Acquired on the Phoenix ICON. Wide-field fundus photograph from neonatal ROP screening. 1240x1240px: 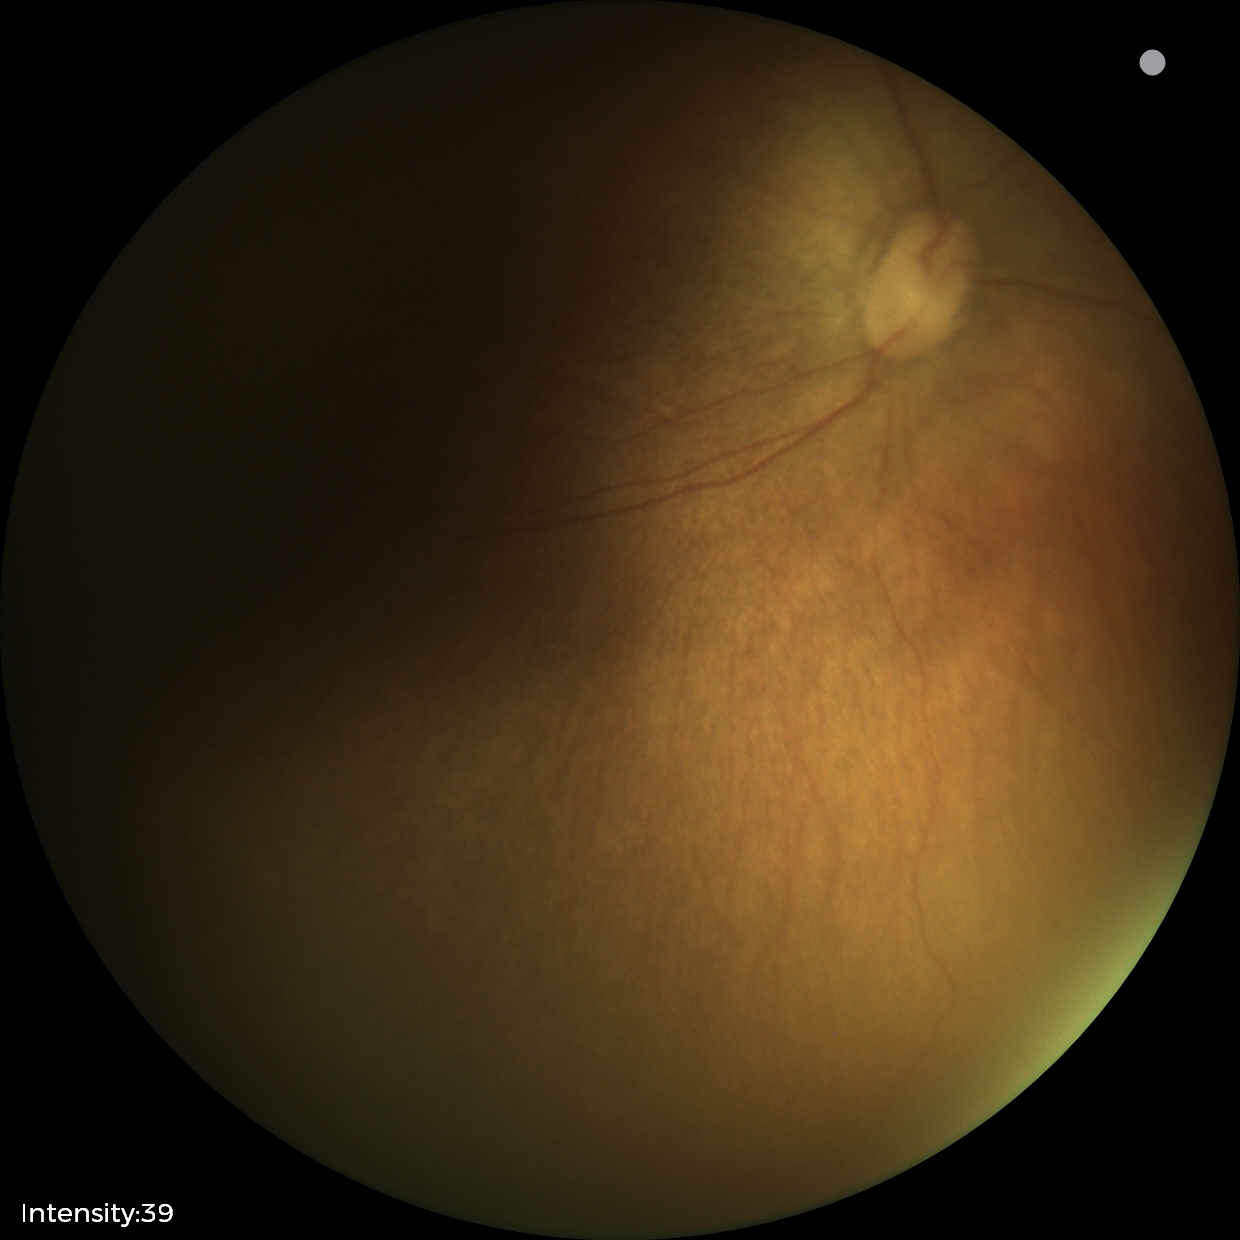
Screening examination with no abnormal retinal findings.